1932x1932px; 45° FOV.
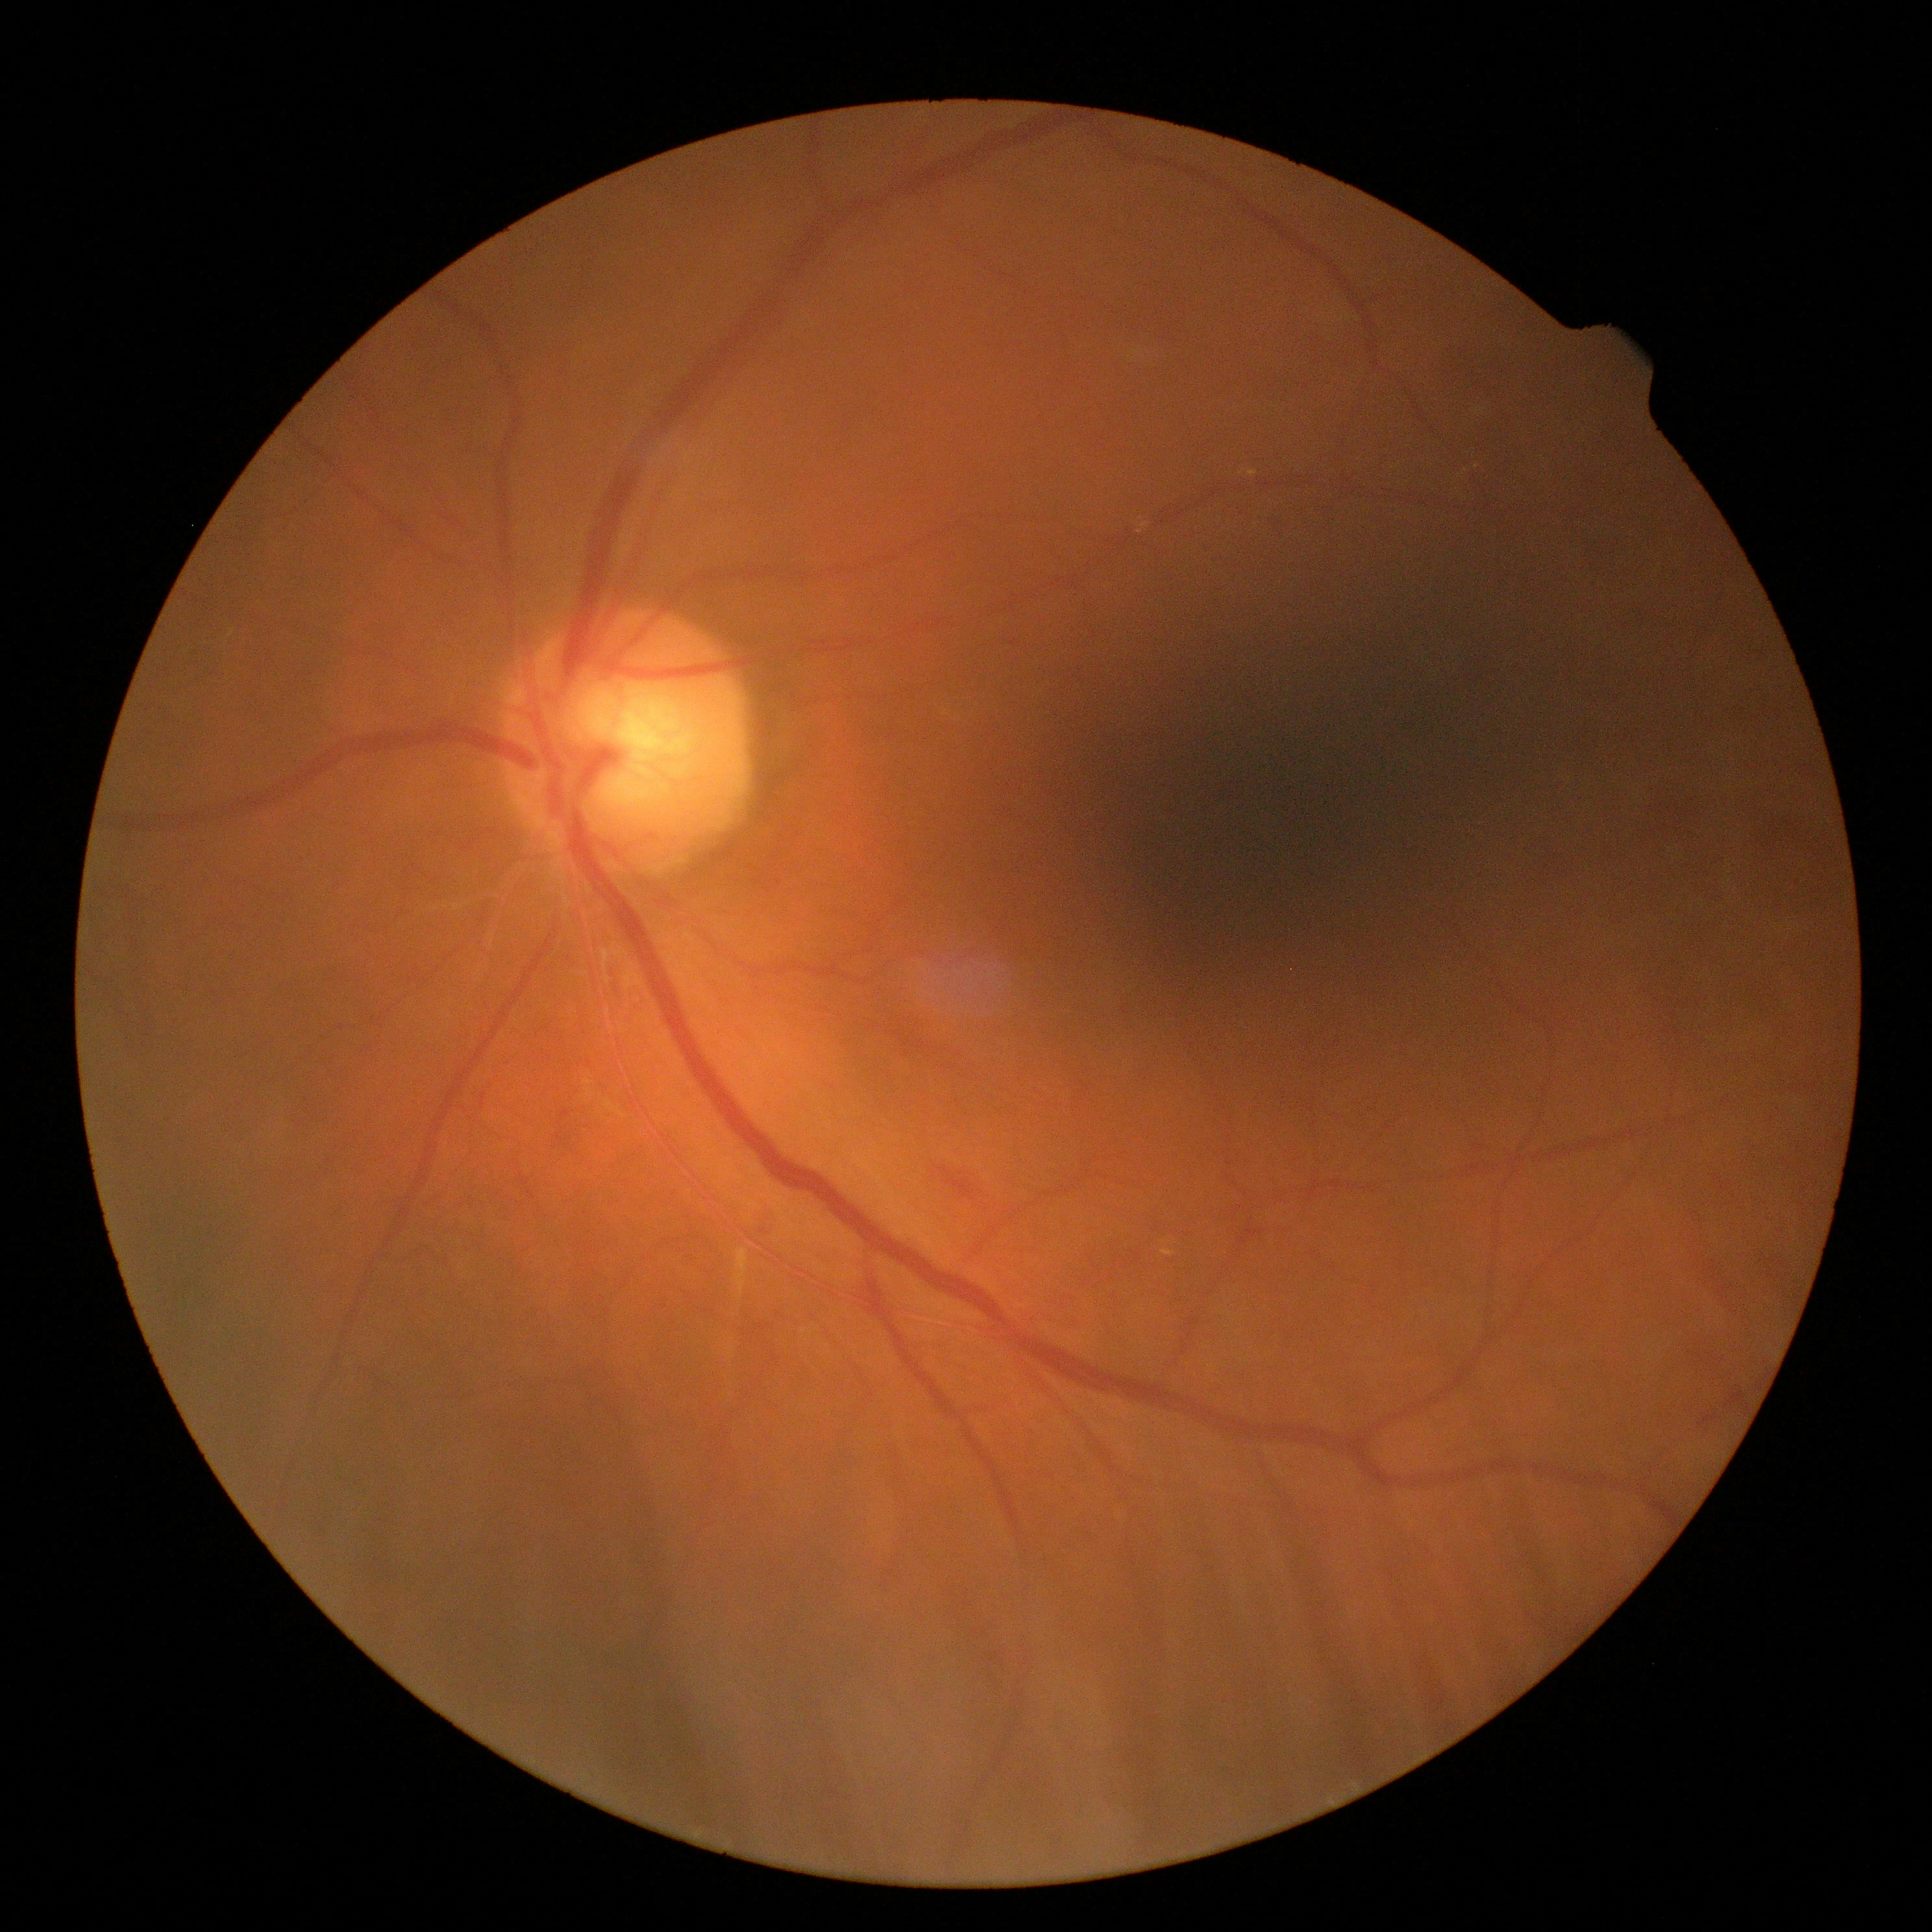

diabetic retinopathy: moderate NPDR (grade 2)